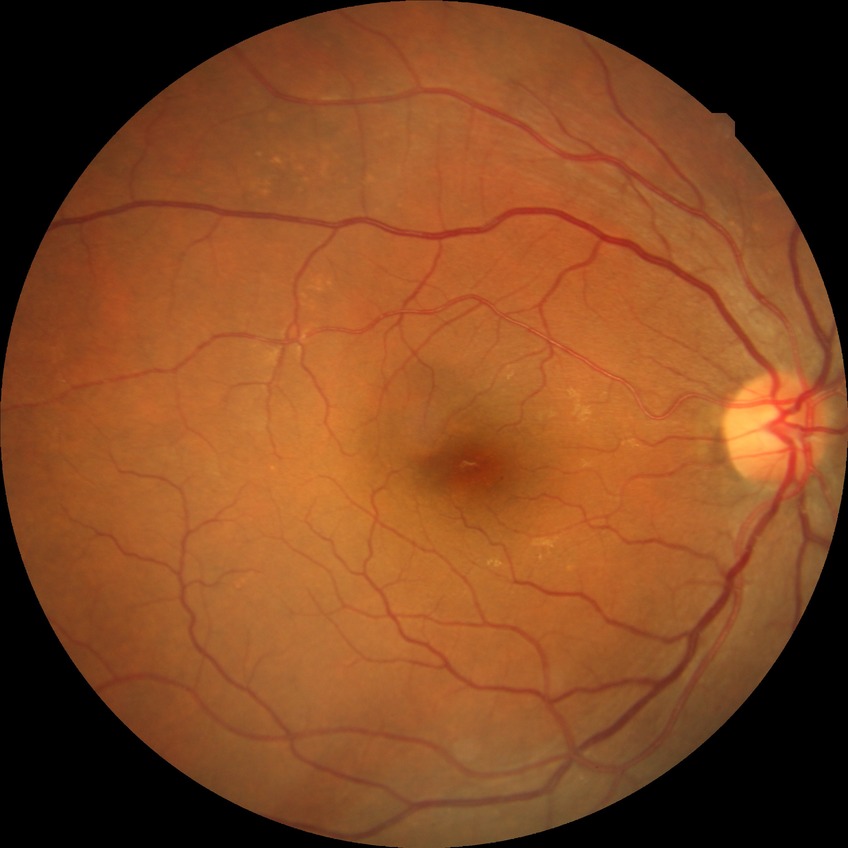
Diabetic retinopathy (DR) is simple diabetic retinopathy (SDR).